Color fundus image; 45-degree field of view; 1380 by 1382 pixels.
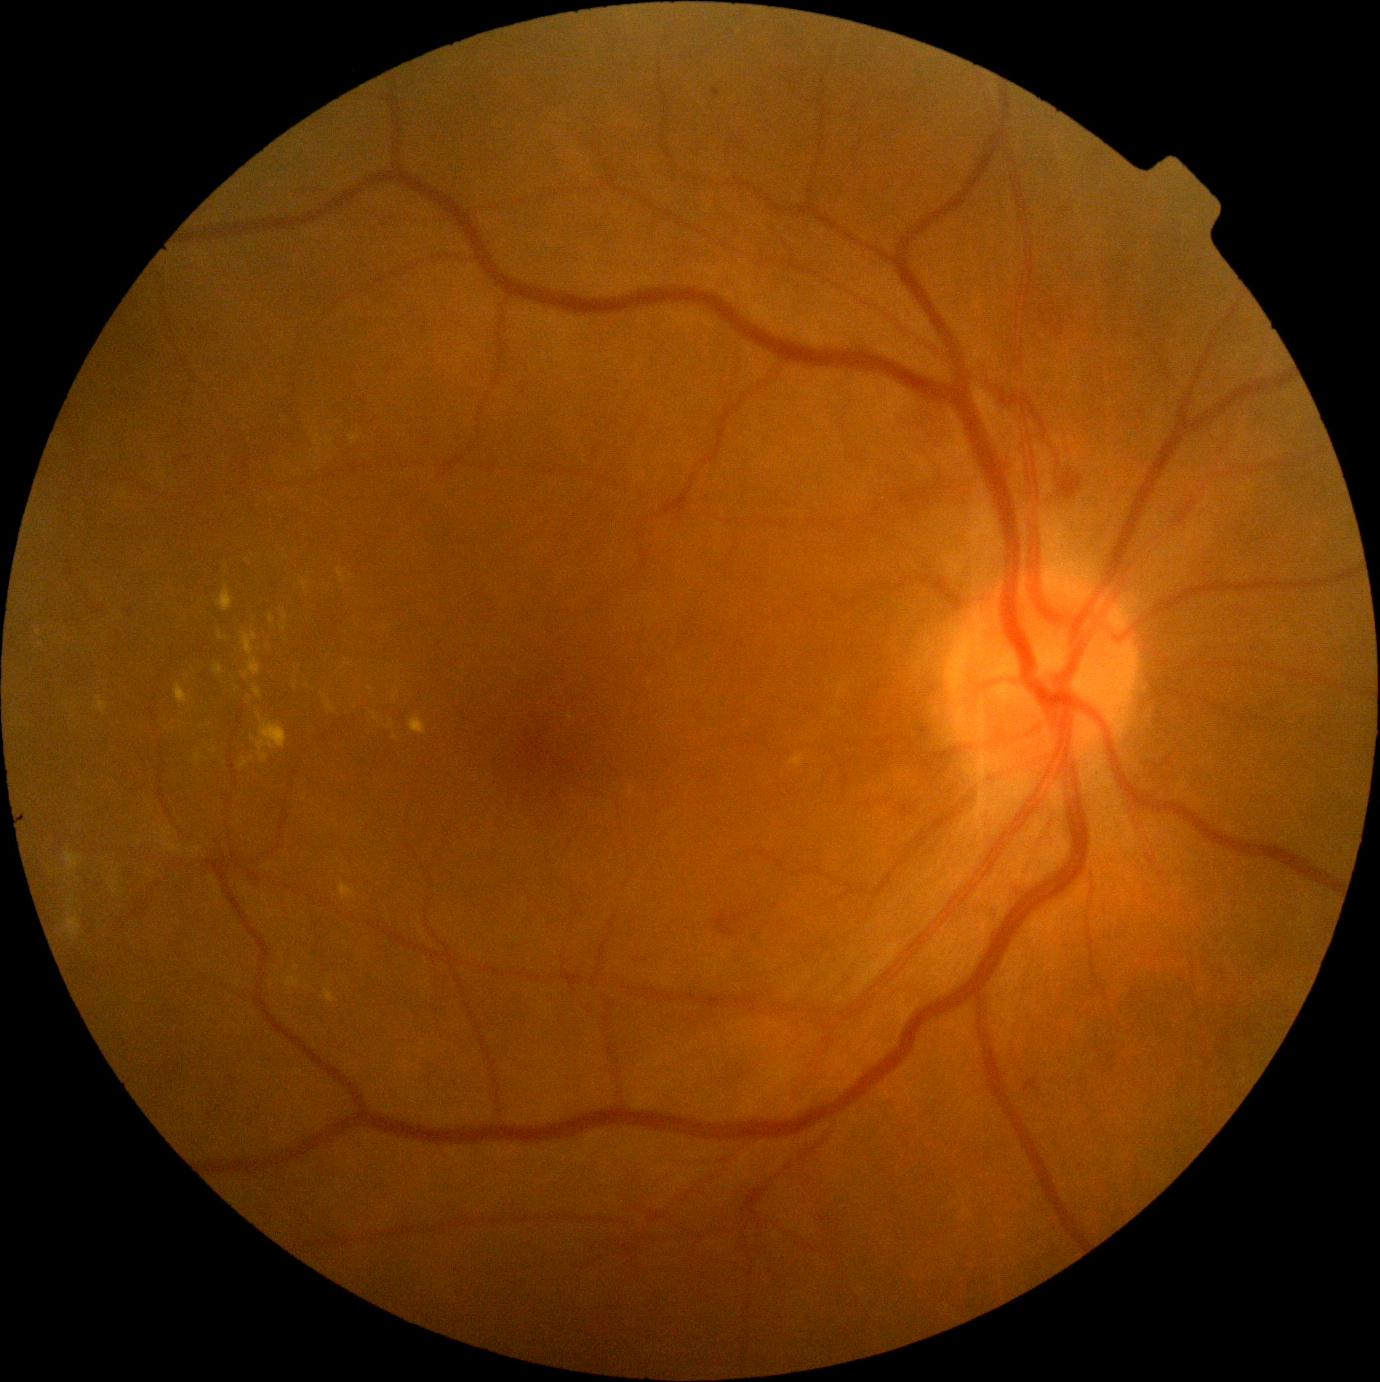 Diabetic retinopathy (DR): grade 2 (moderate NPDR)
Representative lesions:
hemorrhages (HEs) (partial): (1108,1054,1117,1064), (1061,316,1064,324), (901,806,914,816), (1038,306,1046,318), (1047,309,1058,316), (714,912,750,936), (1024,1080,1041,1092), (1039,318,1055,326), (894,399,940,450), (1060,471,1084,489)
HEs (small, approximate centers) near <pt>1048,306</pt>, <pt>1061,335</pt>, <pt>1057,331</pt>
soft exudates (SEs): absent
hard exudates (EXs) (partial): (789,754,805,769), (386,722,394,729), (252,711,288,764), (338,567,347,583), (269,616,276,624), (409,715,427,736), (239,757,249,769), (175,683,189,705), (111,882,117,890), (219,632,229,641), (215,587,235,612), (326,703,336,714), (195,753,203,763)
EXs (small, approximate centers) near <pt>252,759</pt>, <pt>349,665</pt>, <pt>140,843</pt>, <pt>115,871</pt>, <pt>283,628</pt>, <pt>395,737</pt>, <pt>166,727</pt>
microaneurysms (MAs): (712,89,721,98), (1271,948,1280,956), (126,609,134,618), (71,569,74,577), (844,775,849,787)
MAs (small, approximate centers) near <pt>744,143</pt>, <pt>823,1220</pt>